Dilated-pupil acquisition; 2228 x 1652 pixels.
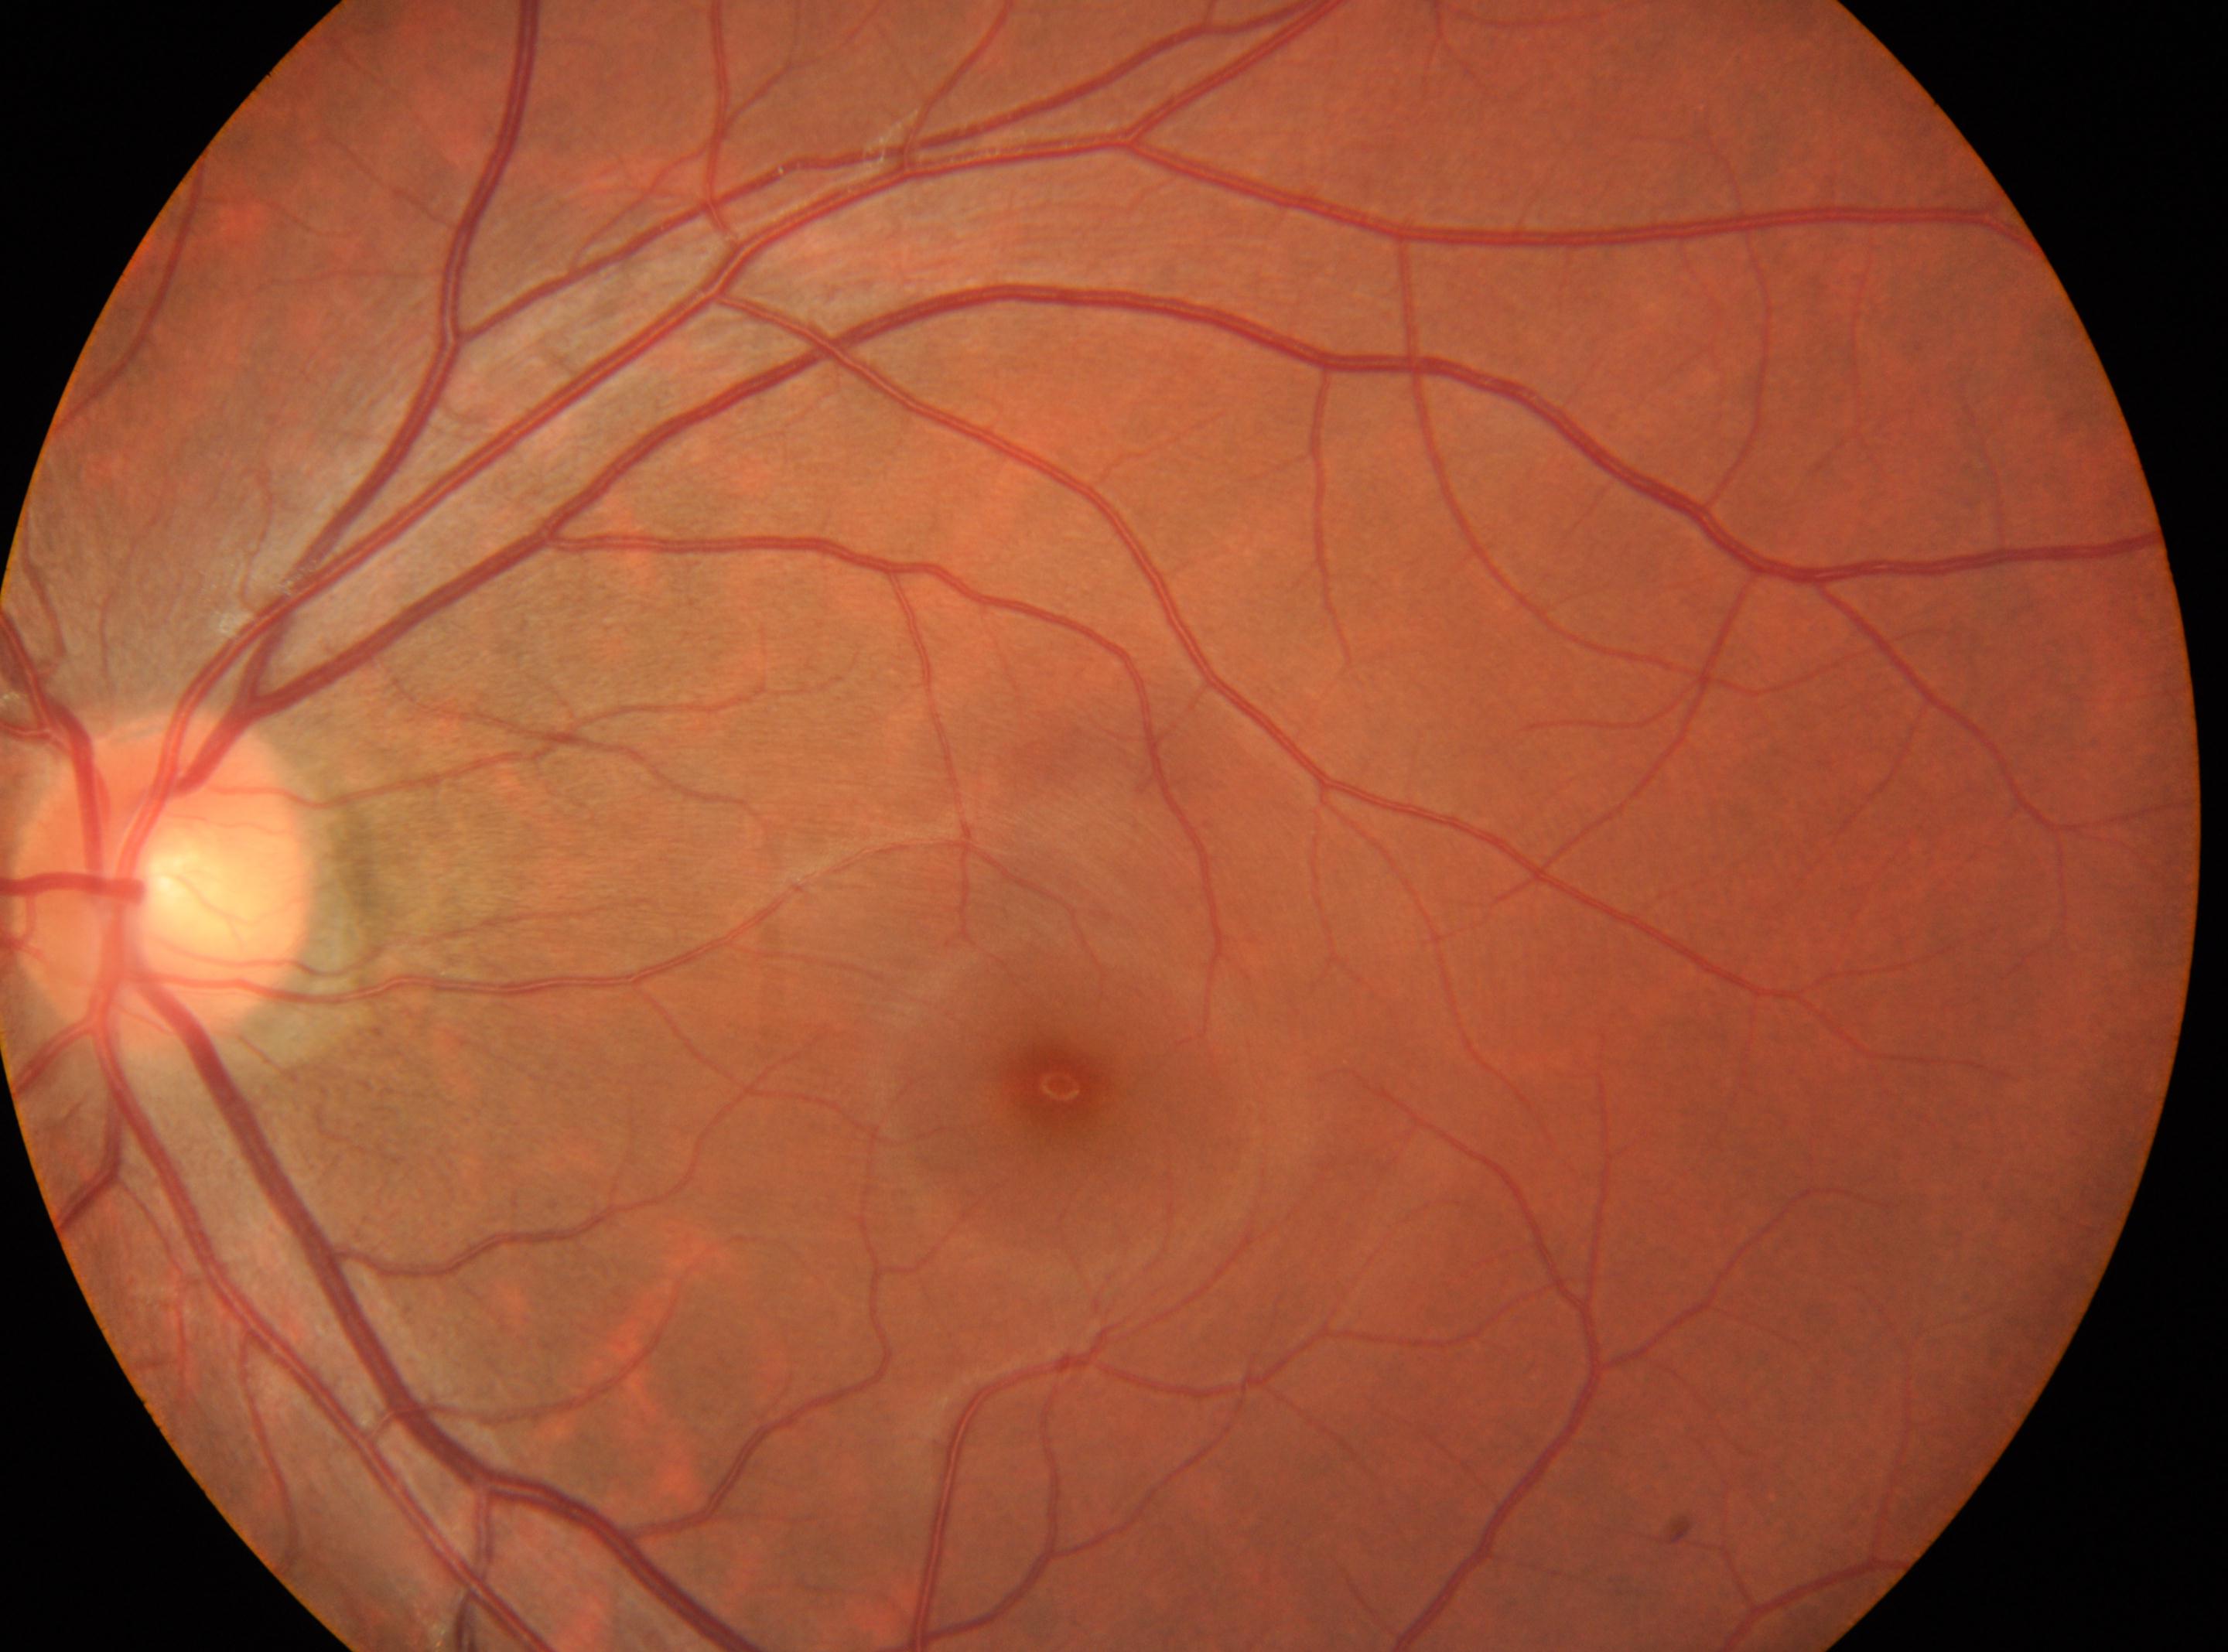

{
  "eye": "the left eye",
  "dr_grade": "0",
  "fovea": "[1058, 1084]",
  "optic_disc": "[161, 884]"
}